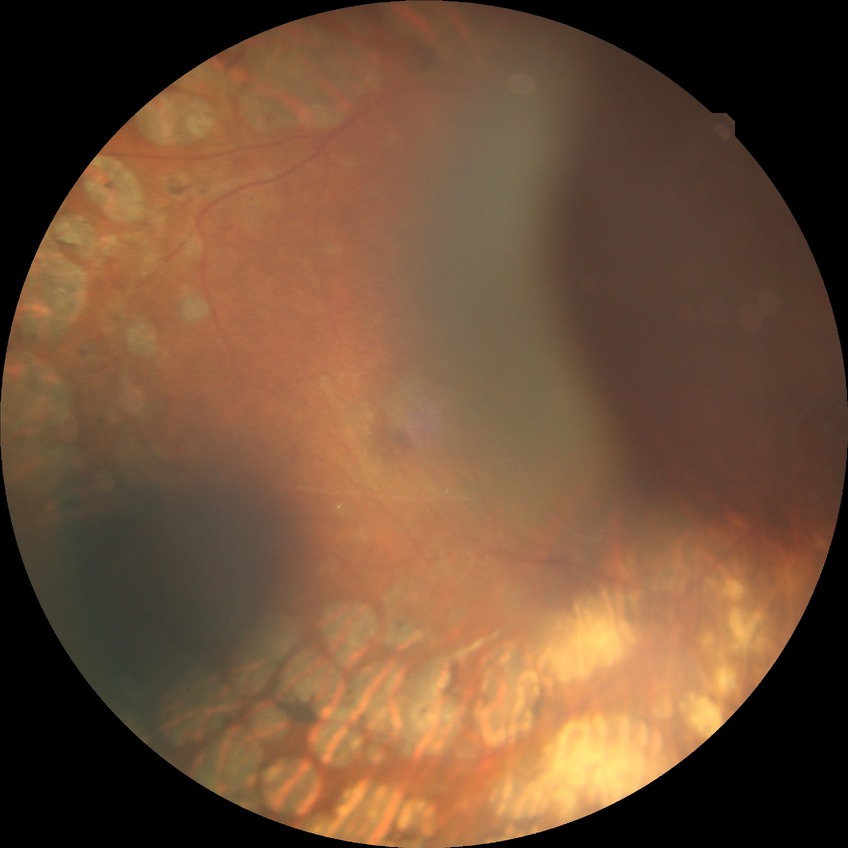

{"davis_grade": "PDR (proliferative diabetic retinopathy)"}